1240 by 1240 pixels · pediatric retinal photograph (wide-field)
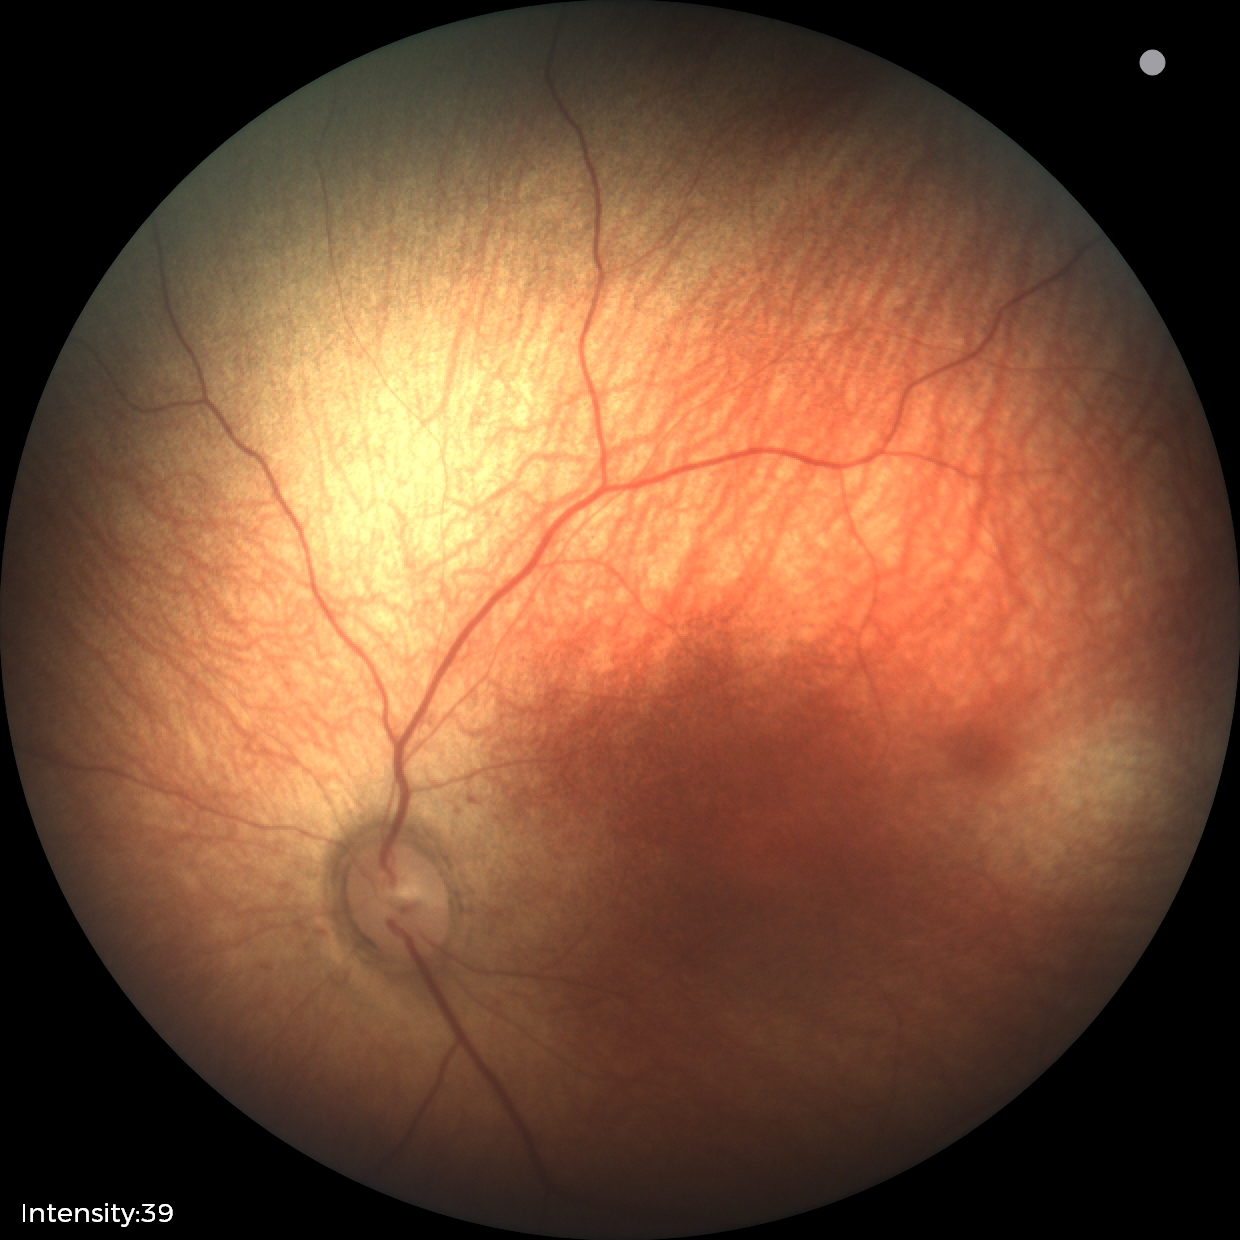
Diagnosis = normal.